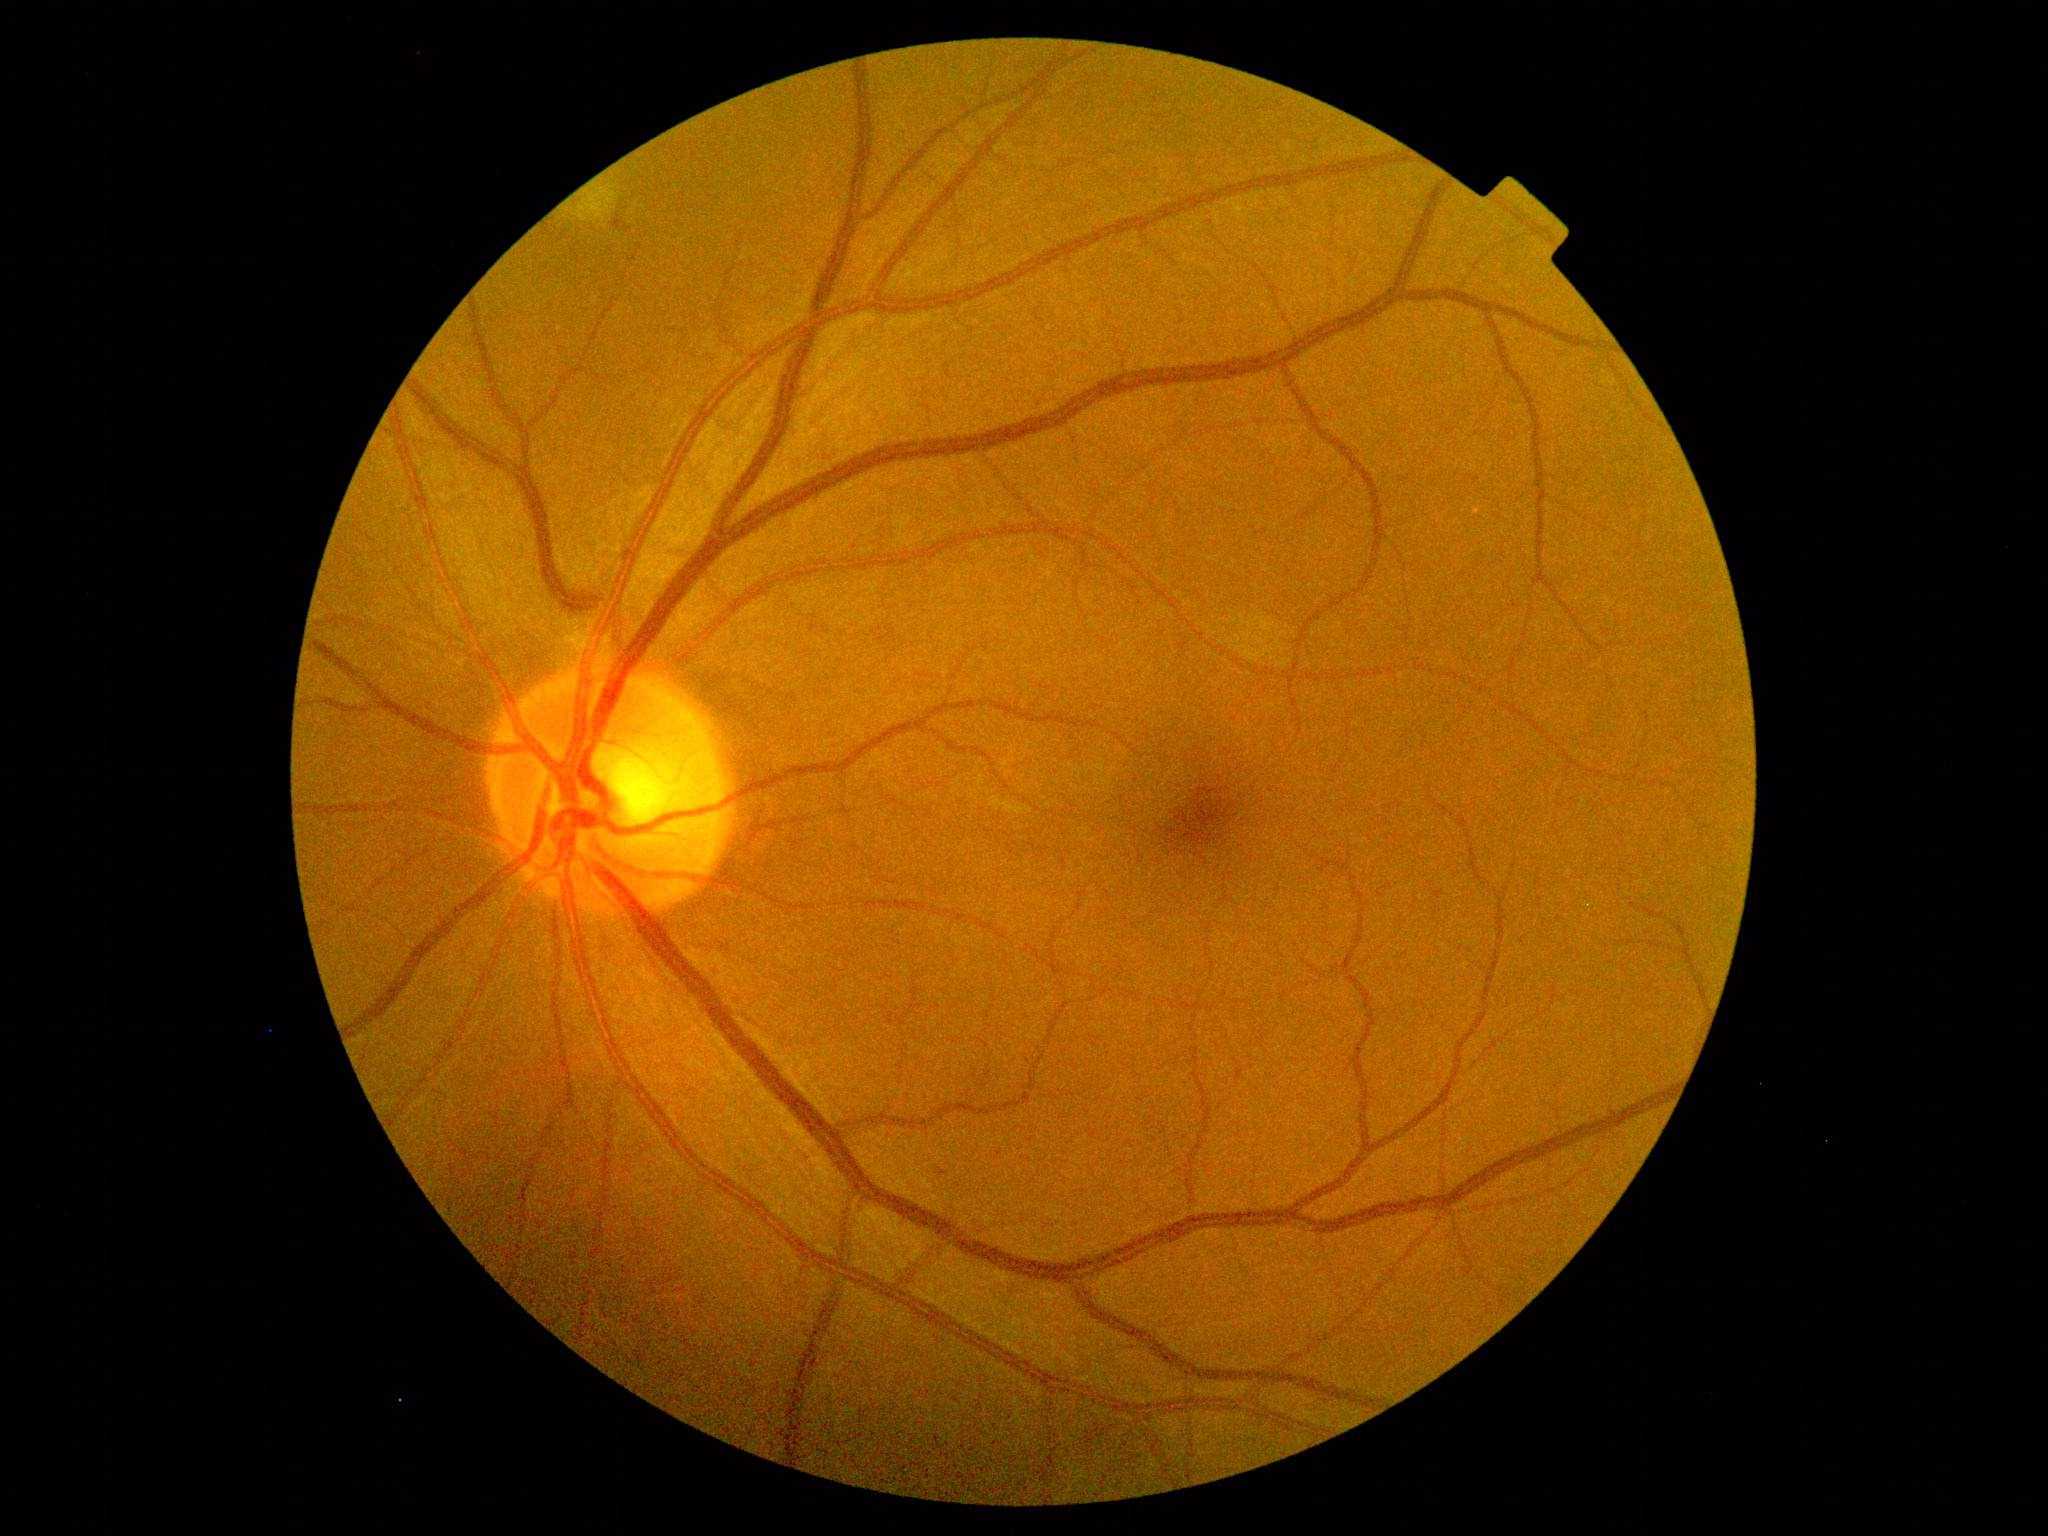 Diabetic retinopathy (DR) is grade 2 (moderate NPDR).
Disease class: non-proliferative diabetic retinopathy.